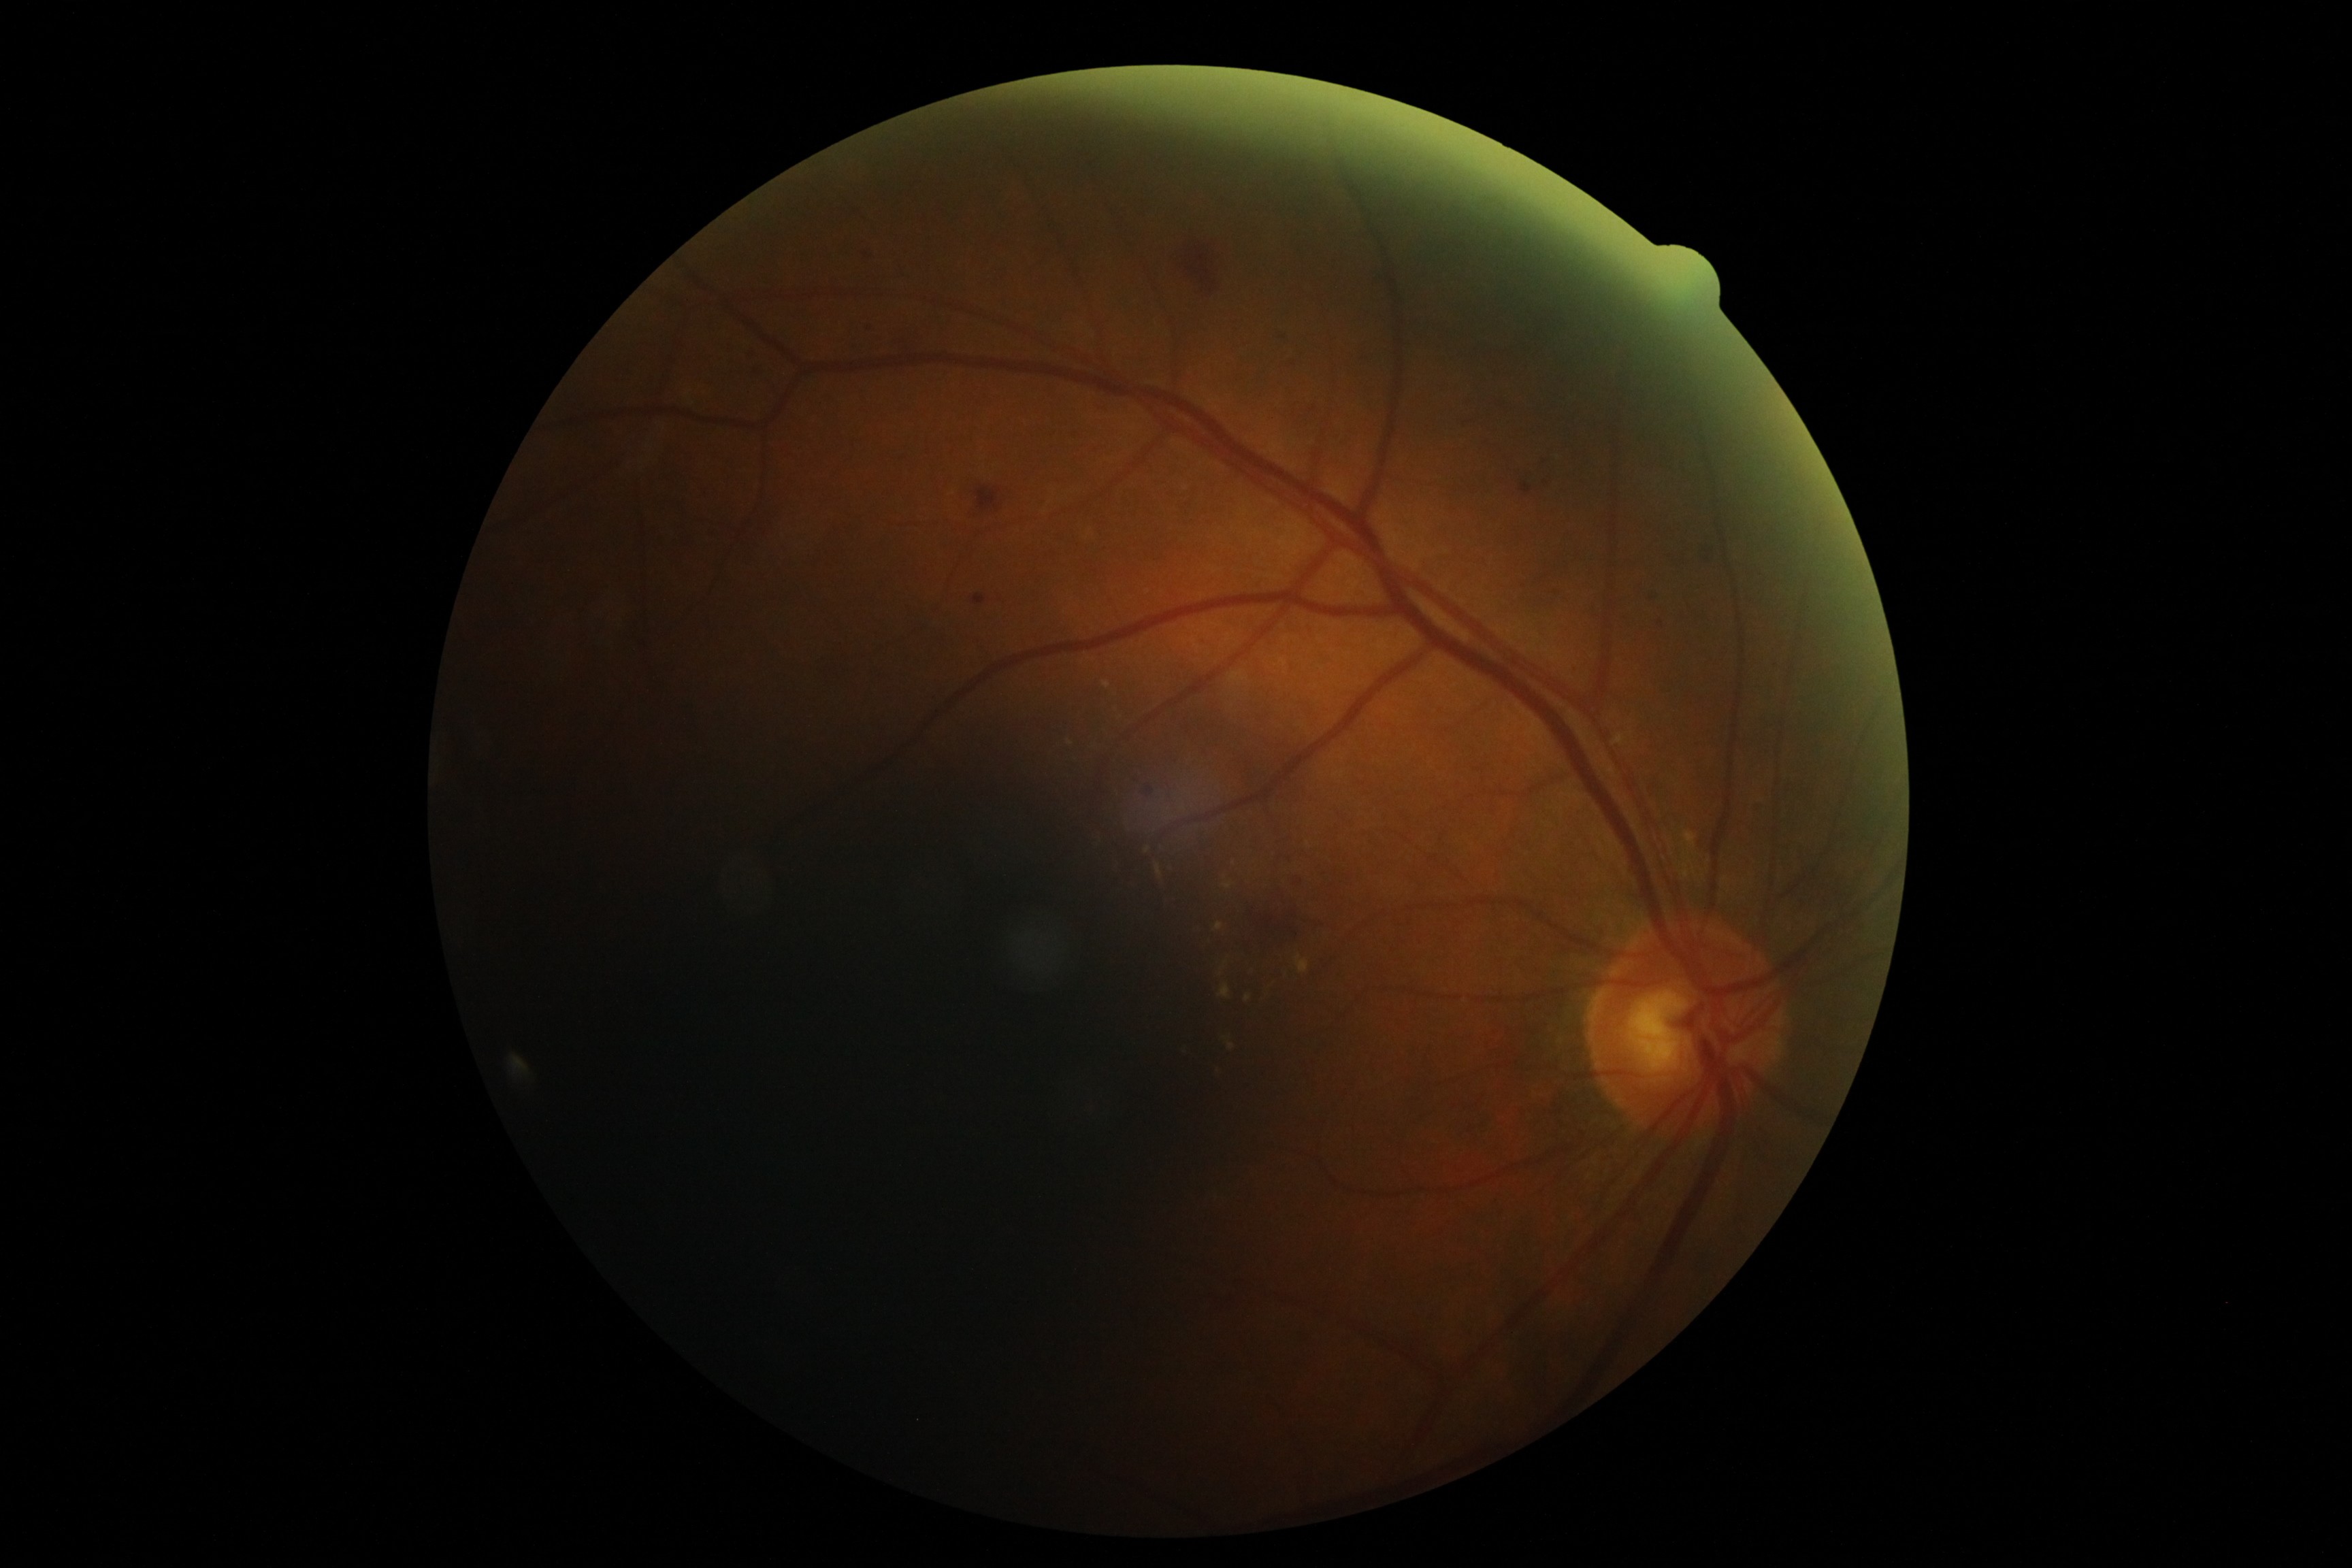 DR is grade 2 (moderate NPDR).